Pediatric retinal photograph (wide-field):
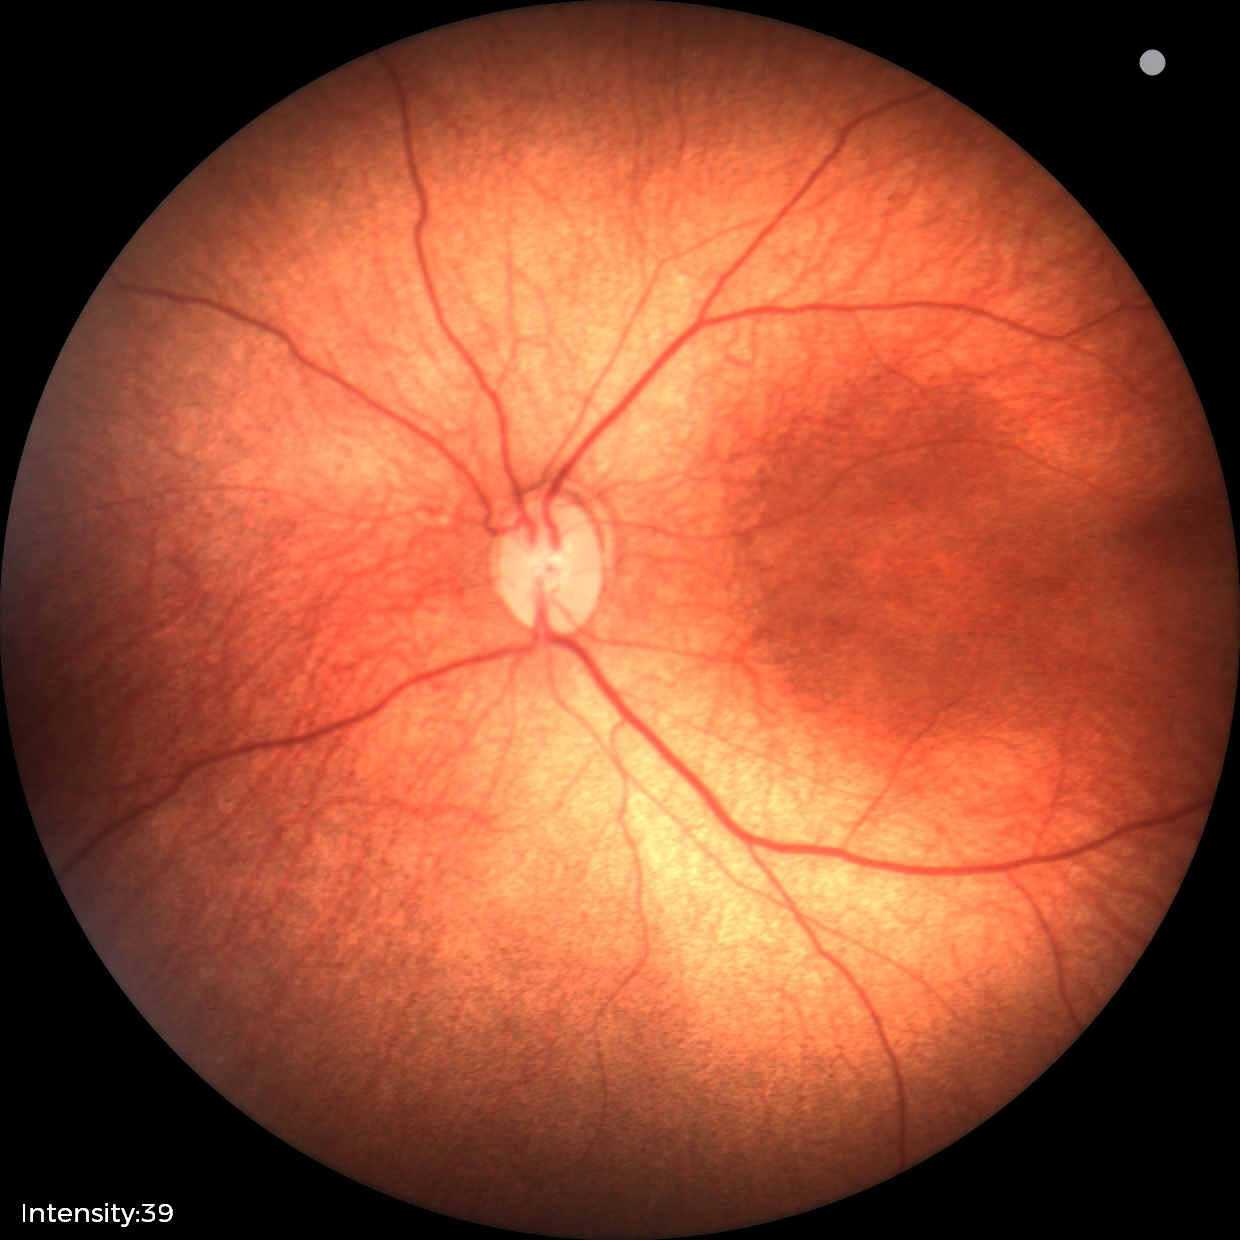
Q: Is plus disease present?
A: no plus disease — posterior pole vessels without abnormal dilation or tortuosity
Q: What is the diagnosis from this examination?
A: status post retinopathy of prematurity (ROP) — retinal appearance after treated retinopathy of prematurity